Ultra-widefield (UWF) fundus image · 1924 x 1556 pixels: 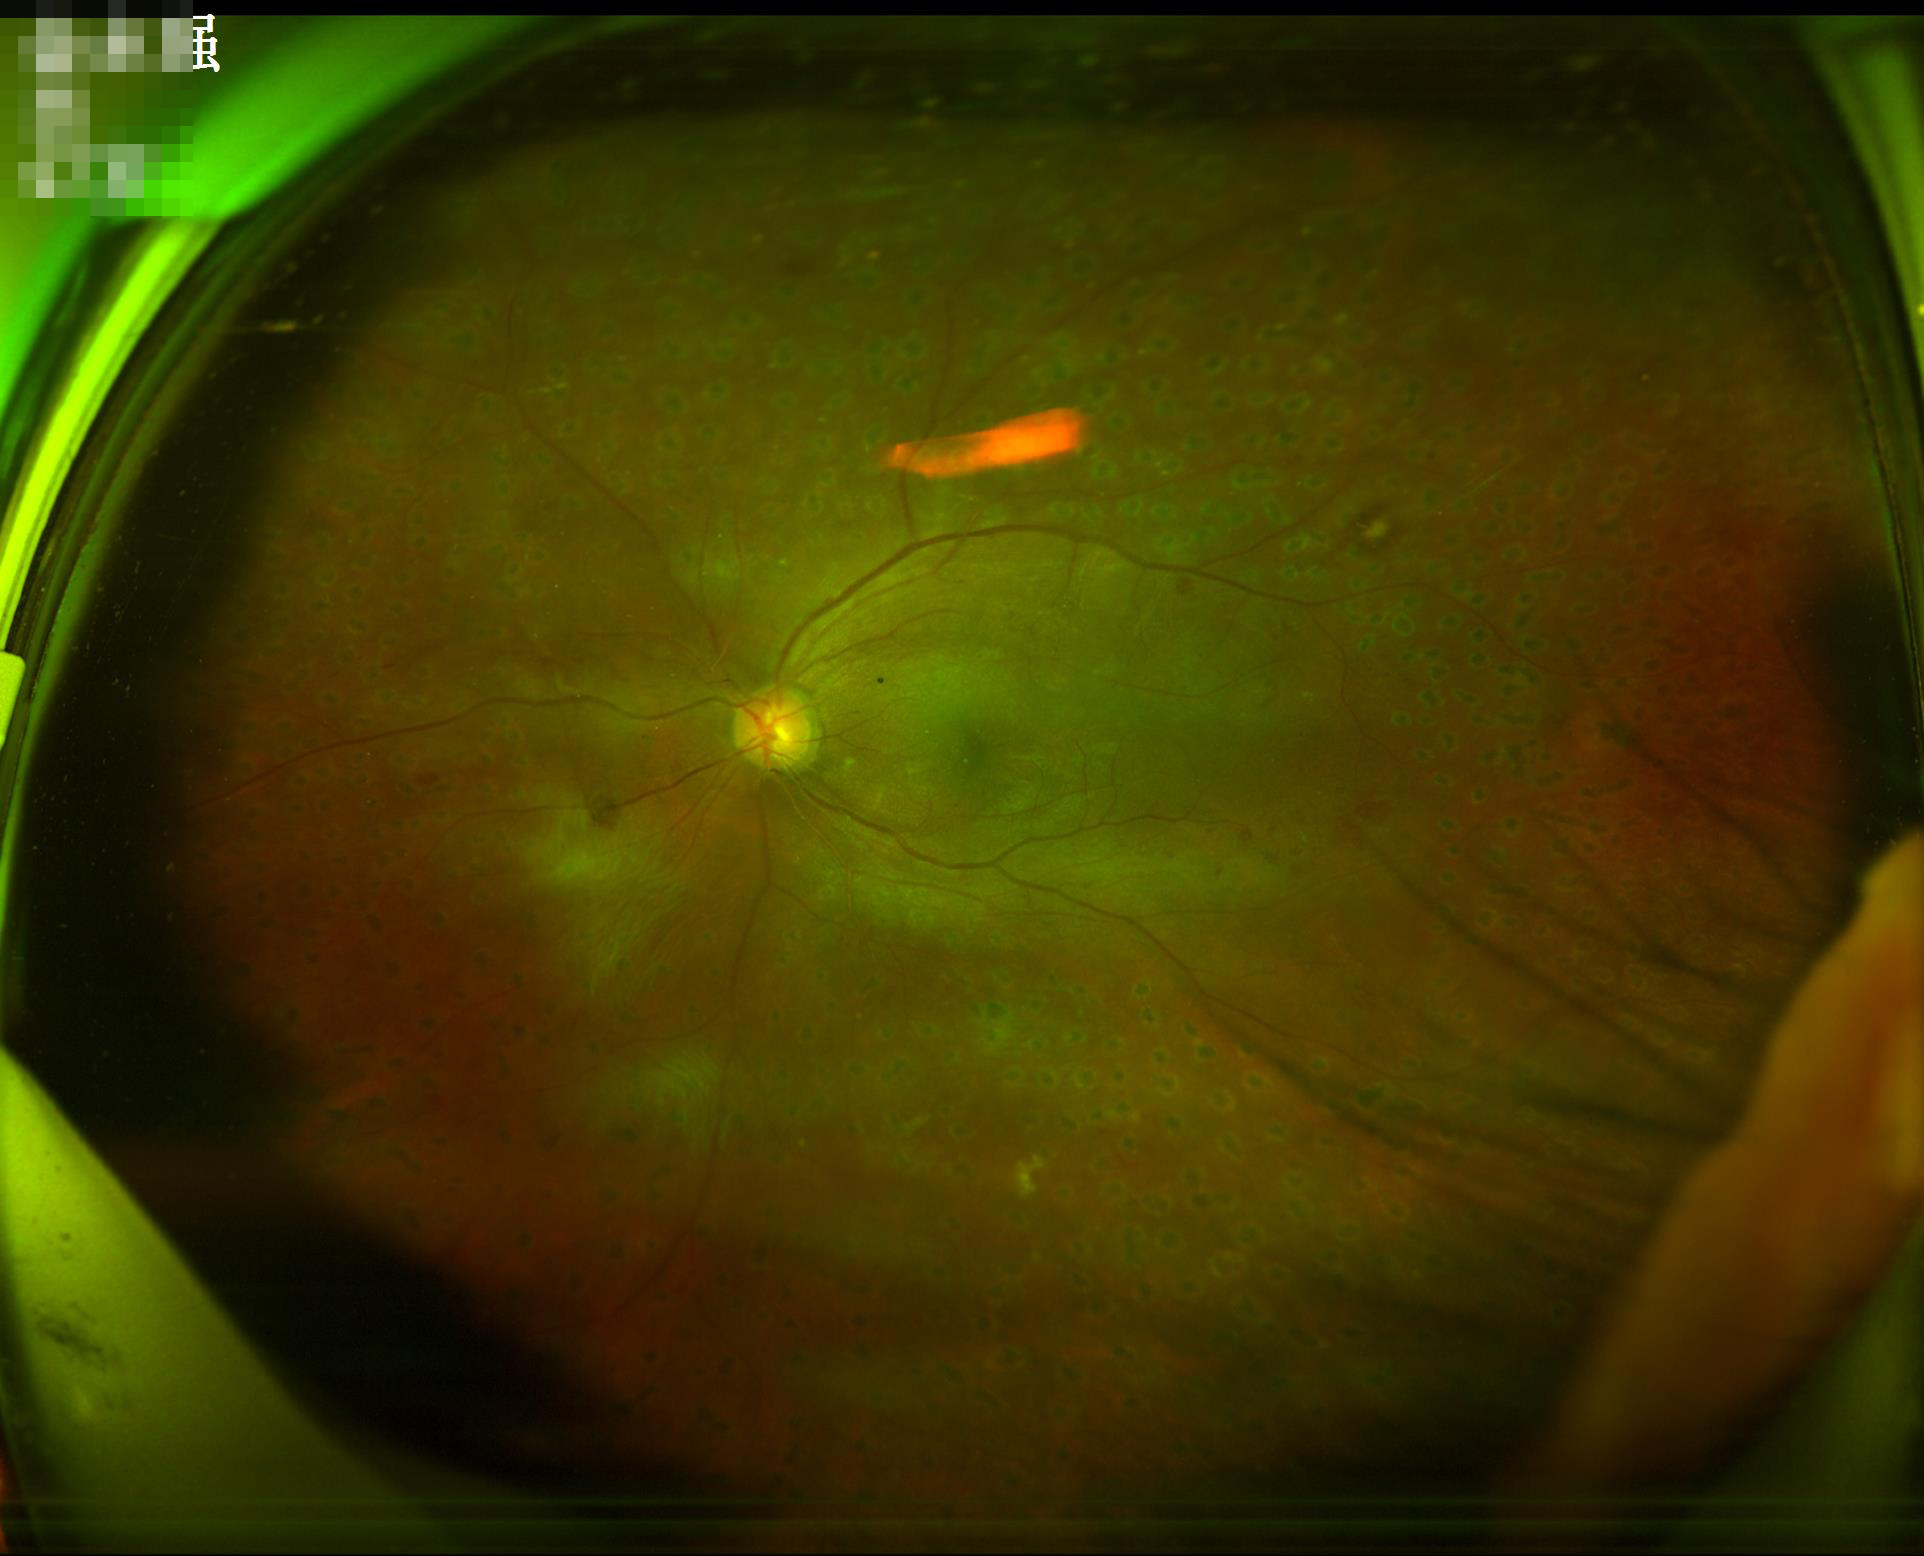
No over- or under-exposure. Good dynamic range. Overall image quality is good. The image is blurry.